CFP · 45-degree field of view.
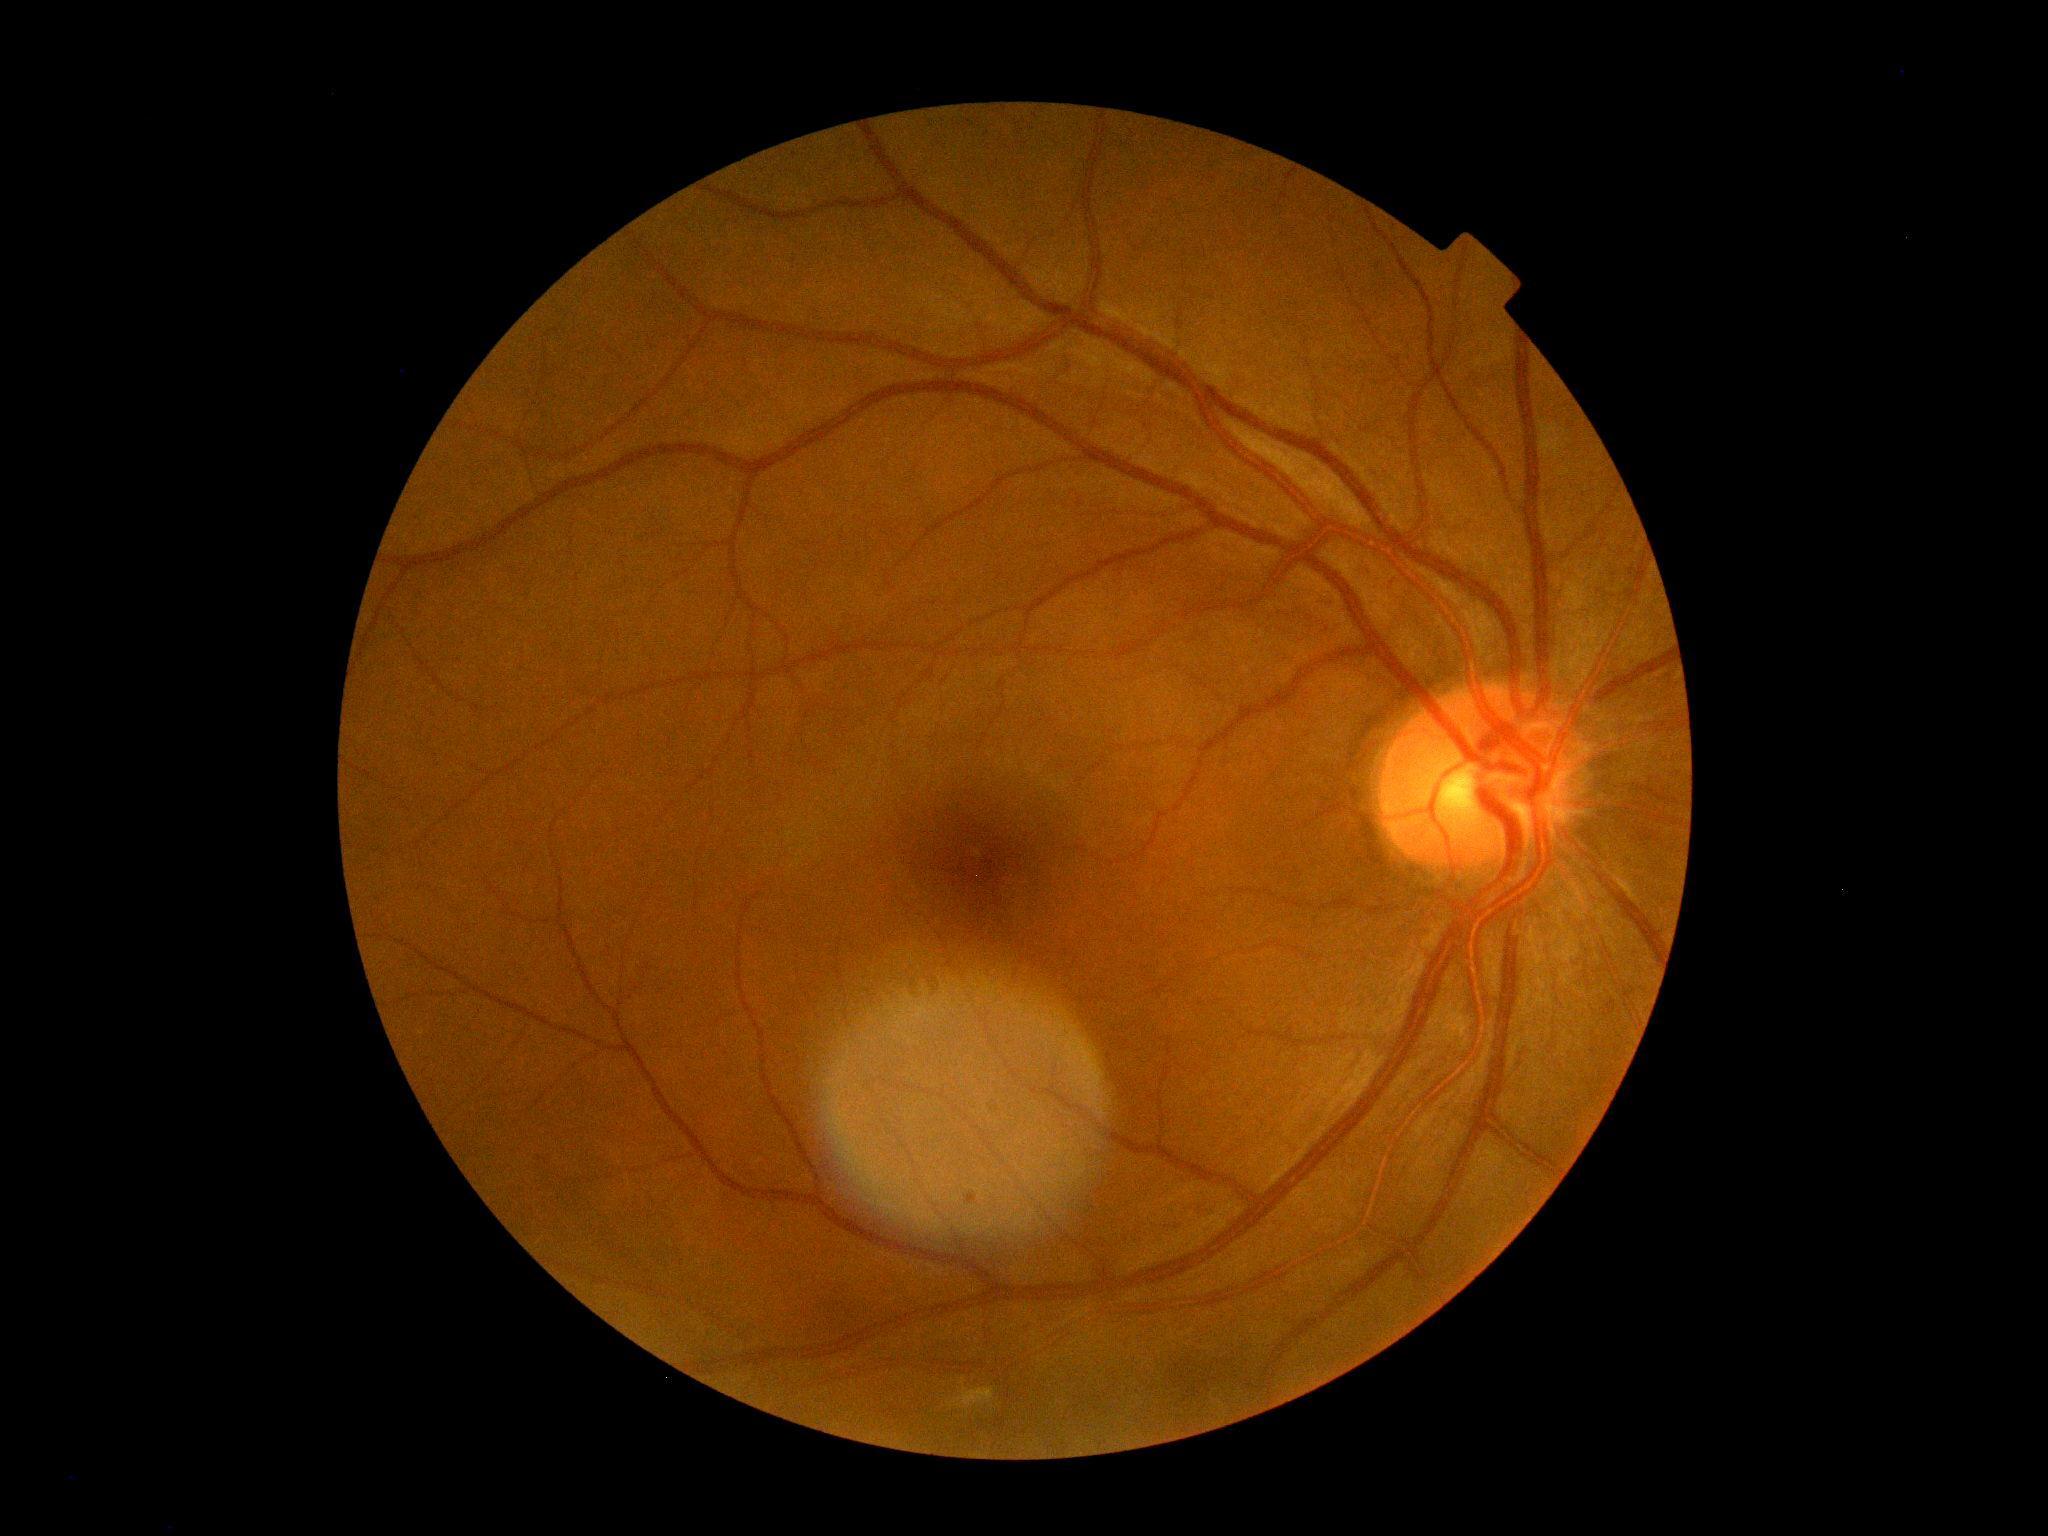

Diabetic retinopathy (DR): grade 0 (no apparent retinopathy).